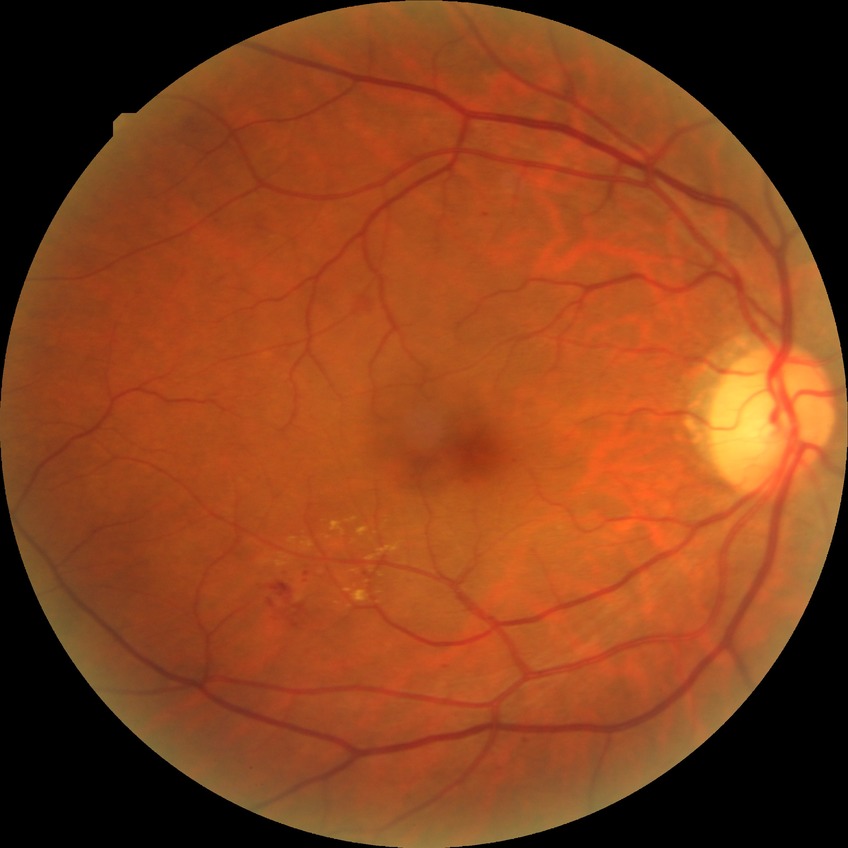 Disease class: non-proliferative diabetic retinopathy.
Retinopathy grade: simple diabetic retinopathy.